1659 by 2212 pixels
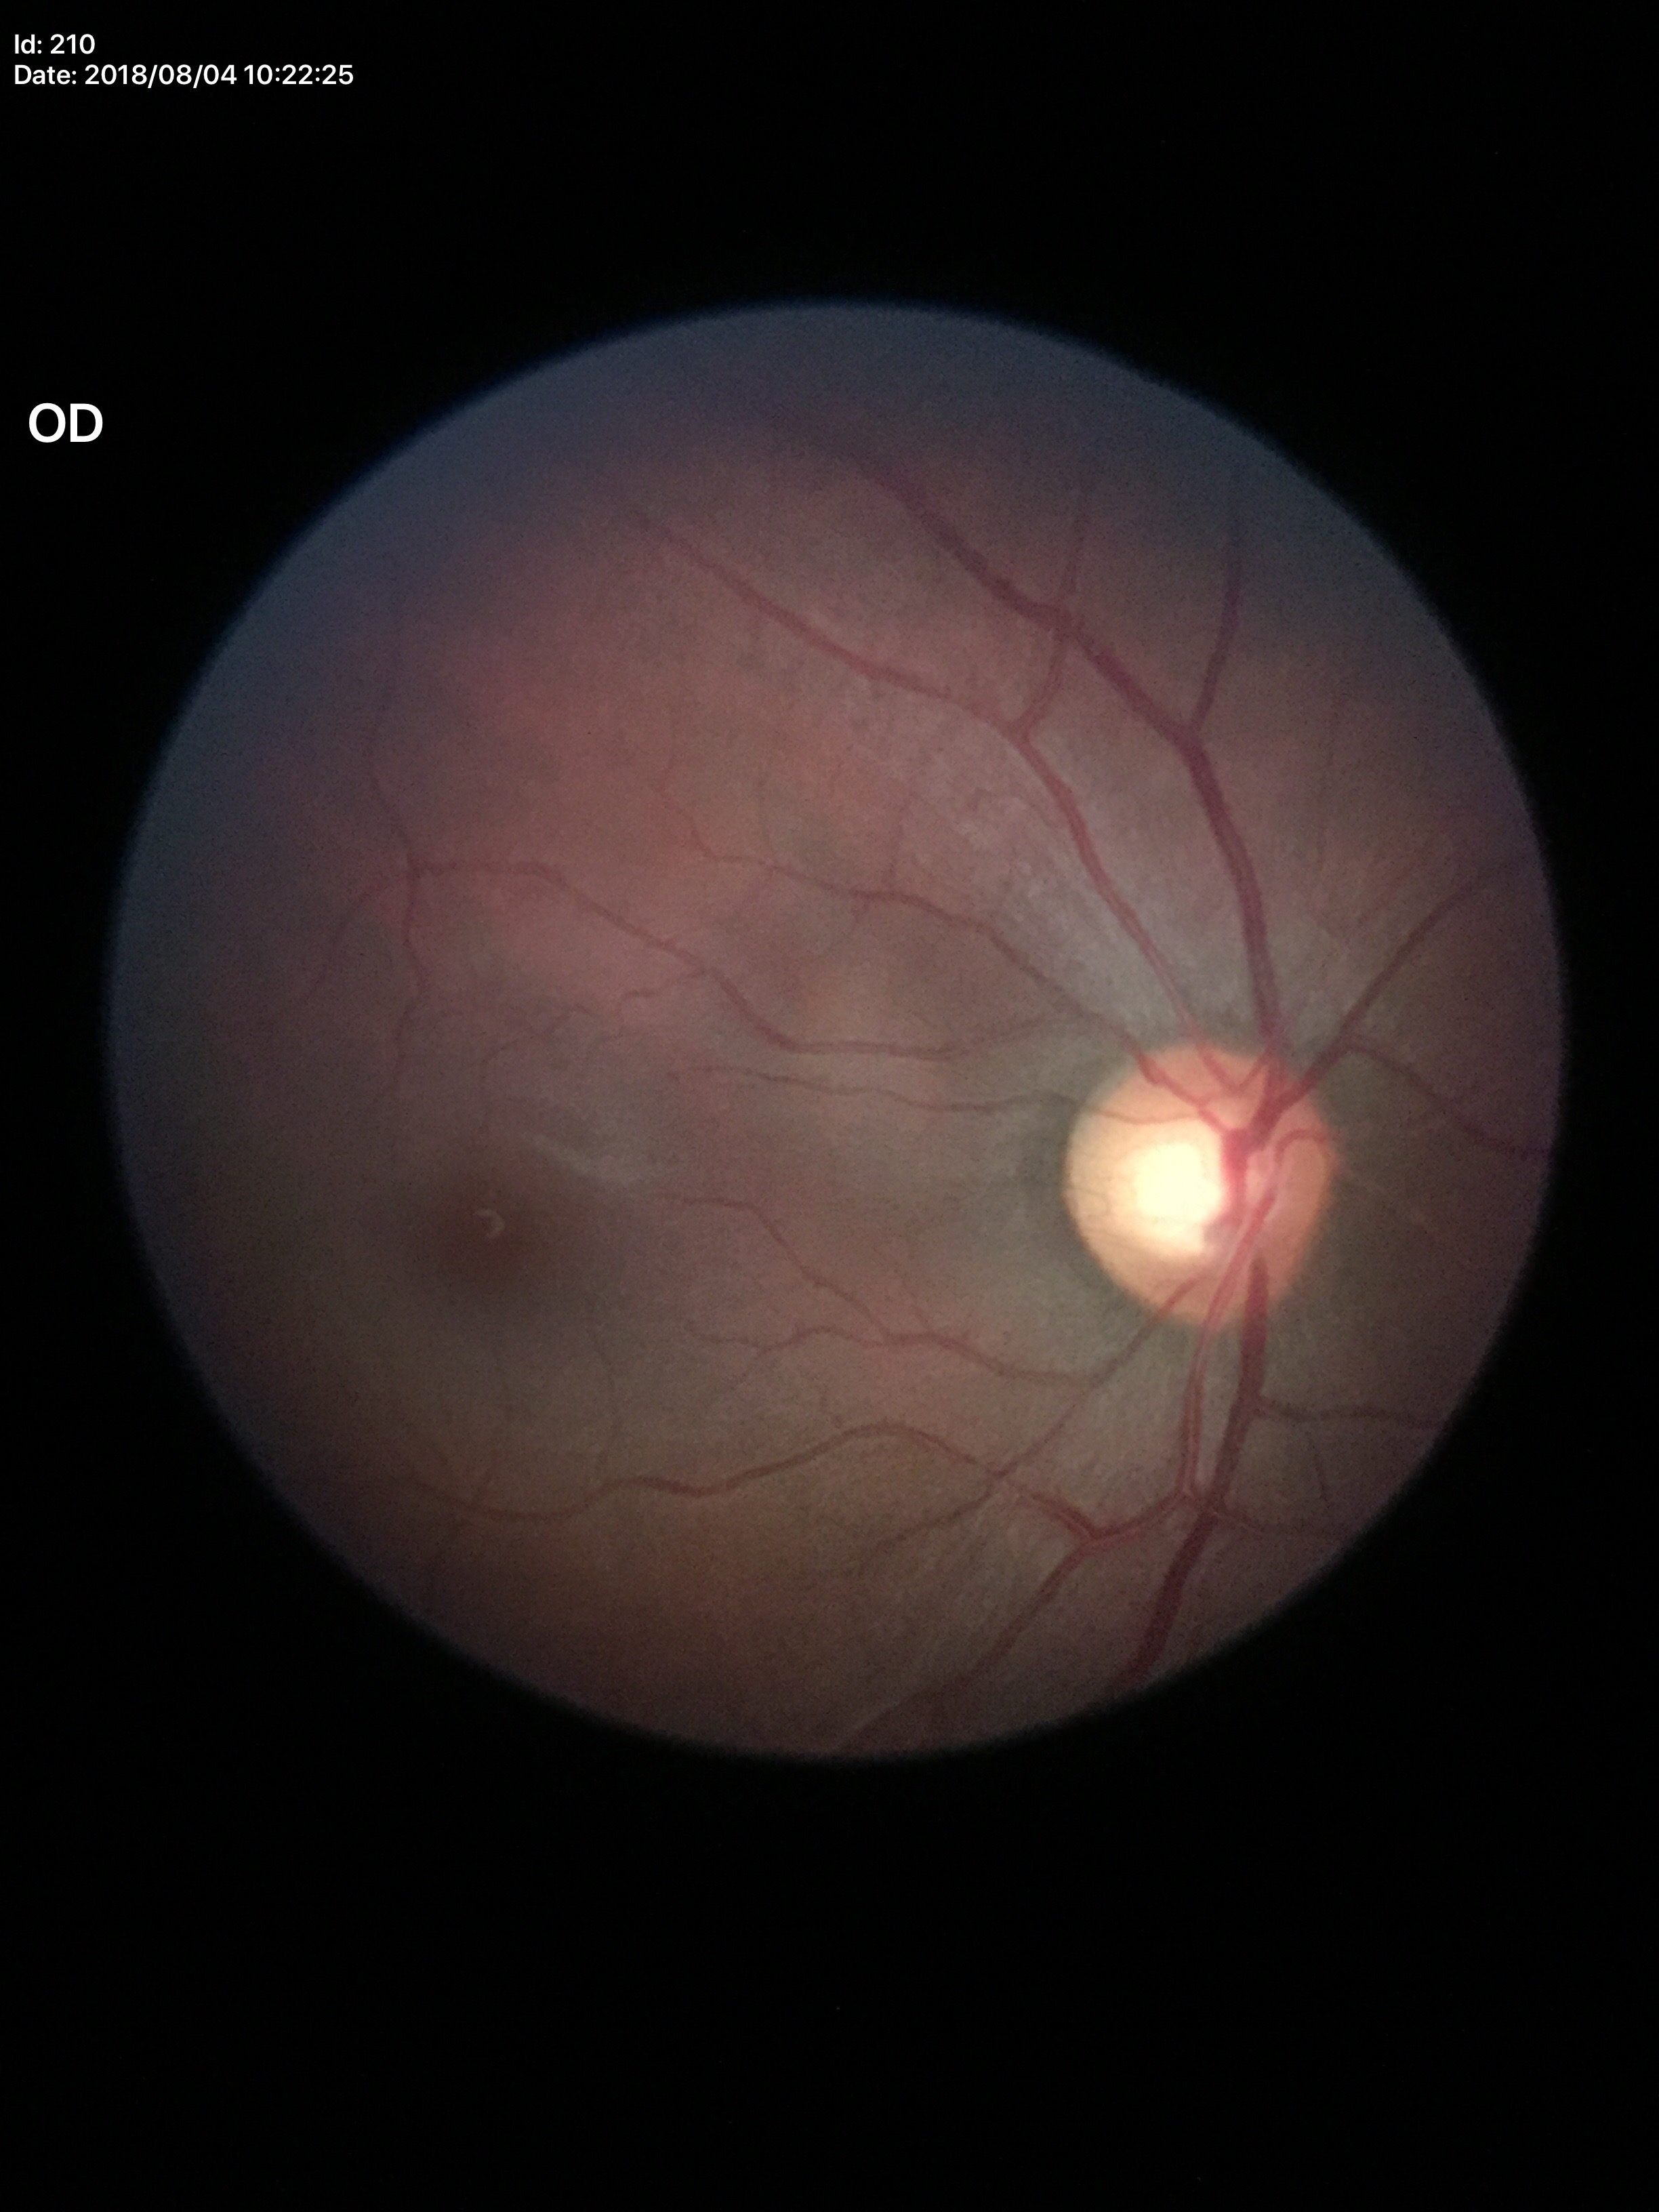
vertical cup-disc ratio (VCDR) = 0.59 | Glaucoma assessment = no suspicious findings (one of five ophthalmologists flagged glaucoma suspect).